Diabetic retinopathy graded by the modified Davis classification, nonmydriatic:
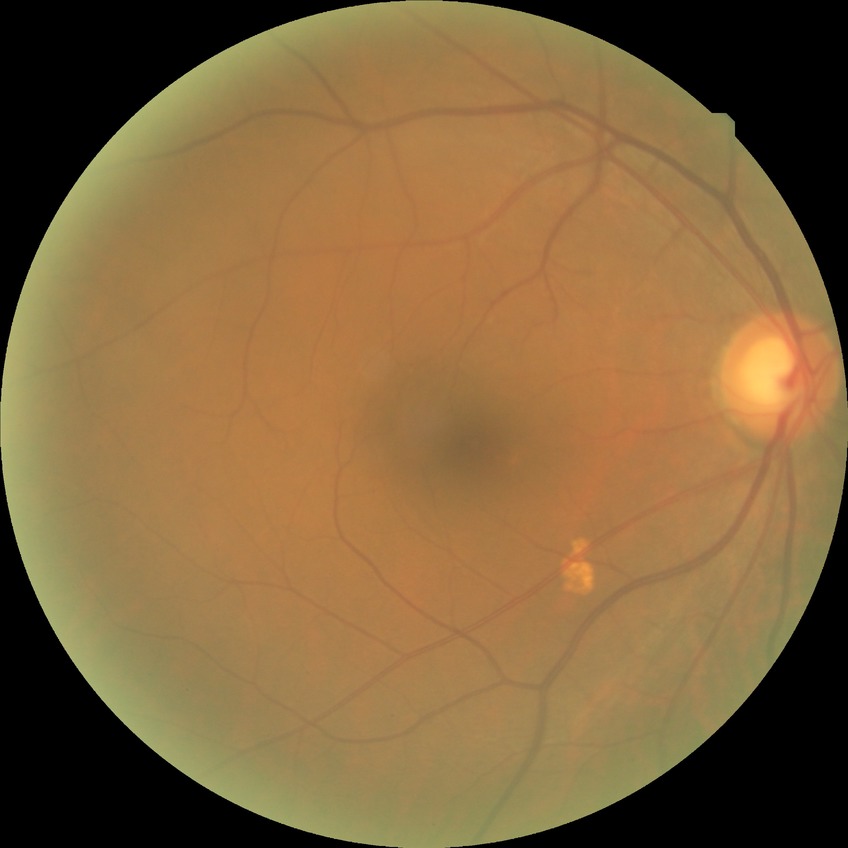

Diabetic retinopathy (DR) is NDR (no diabetic retinopathy).